2352 x 1568 pixels · 45° FOV — 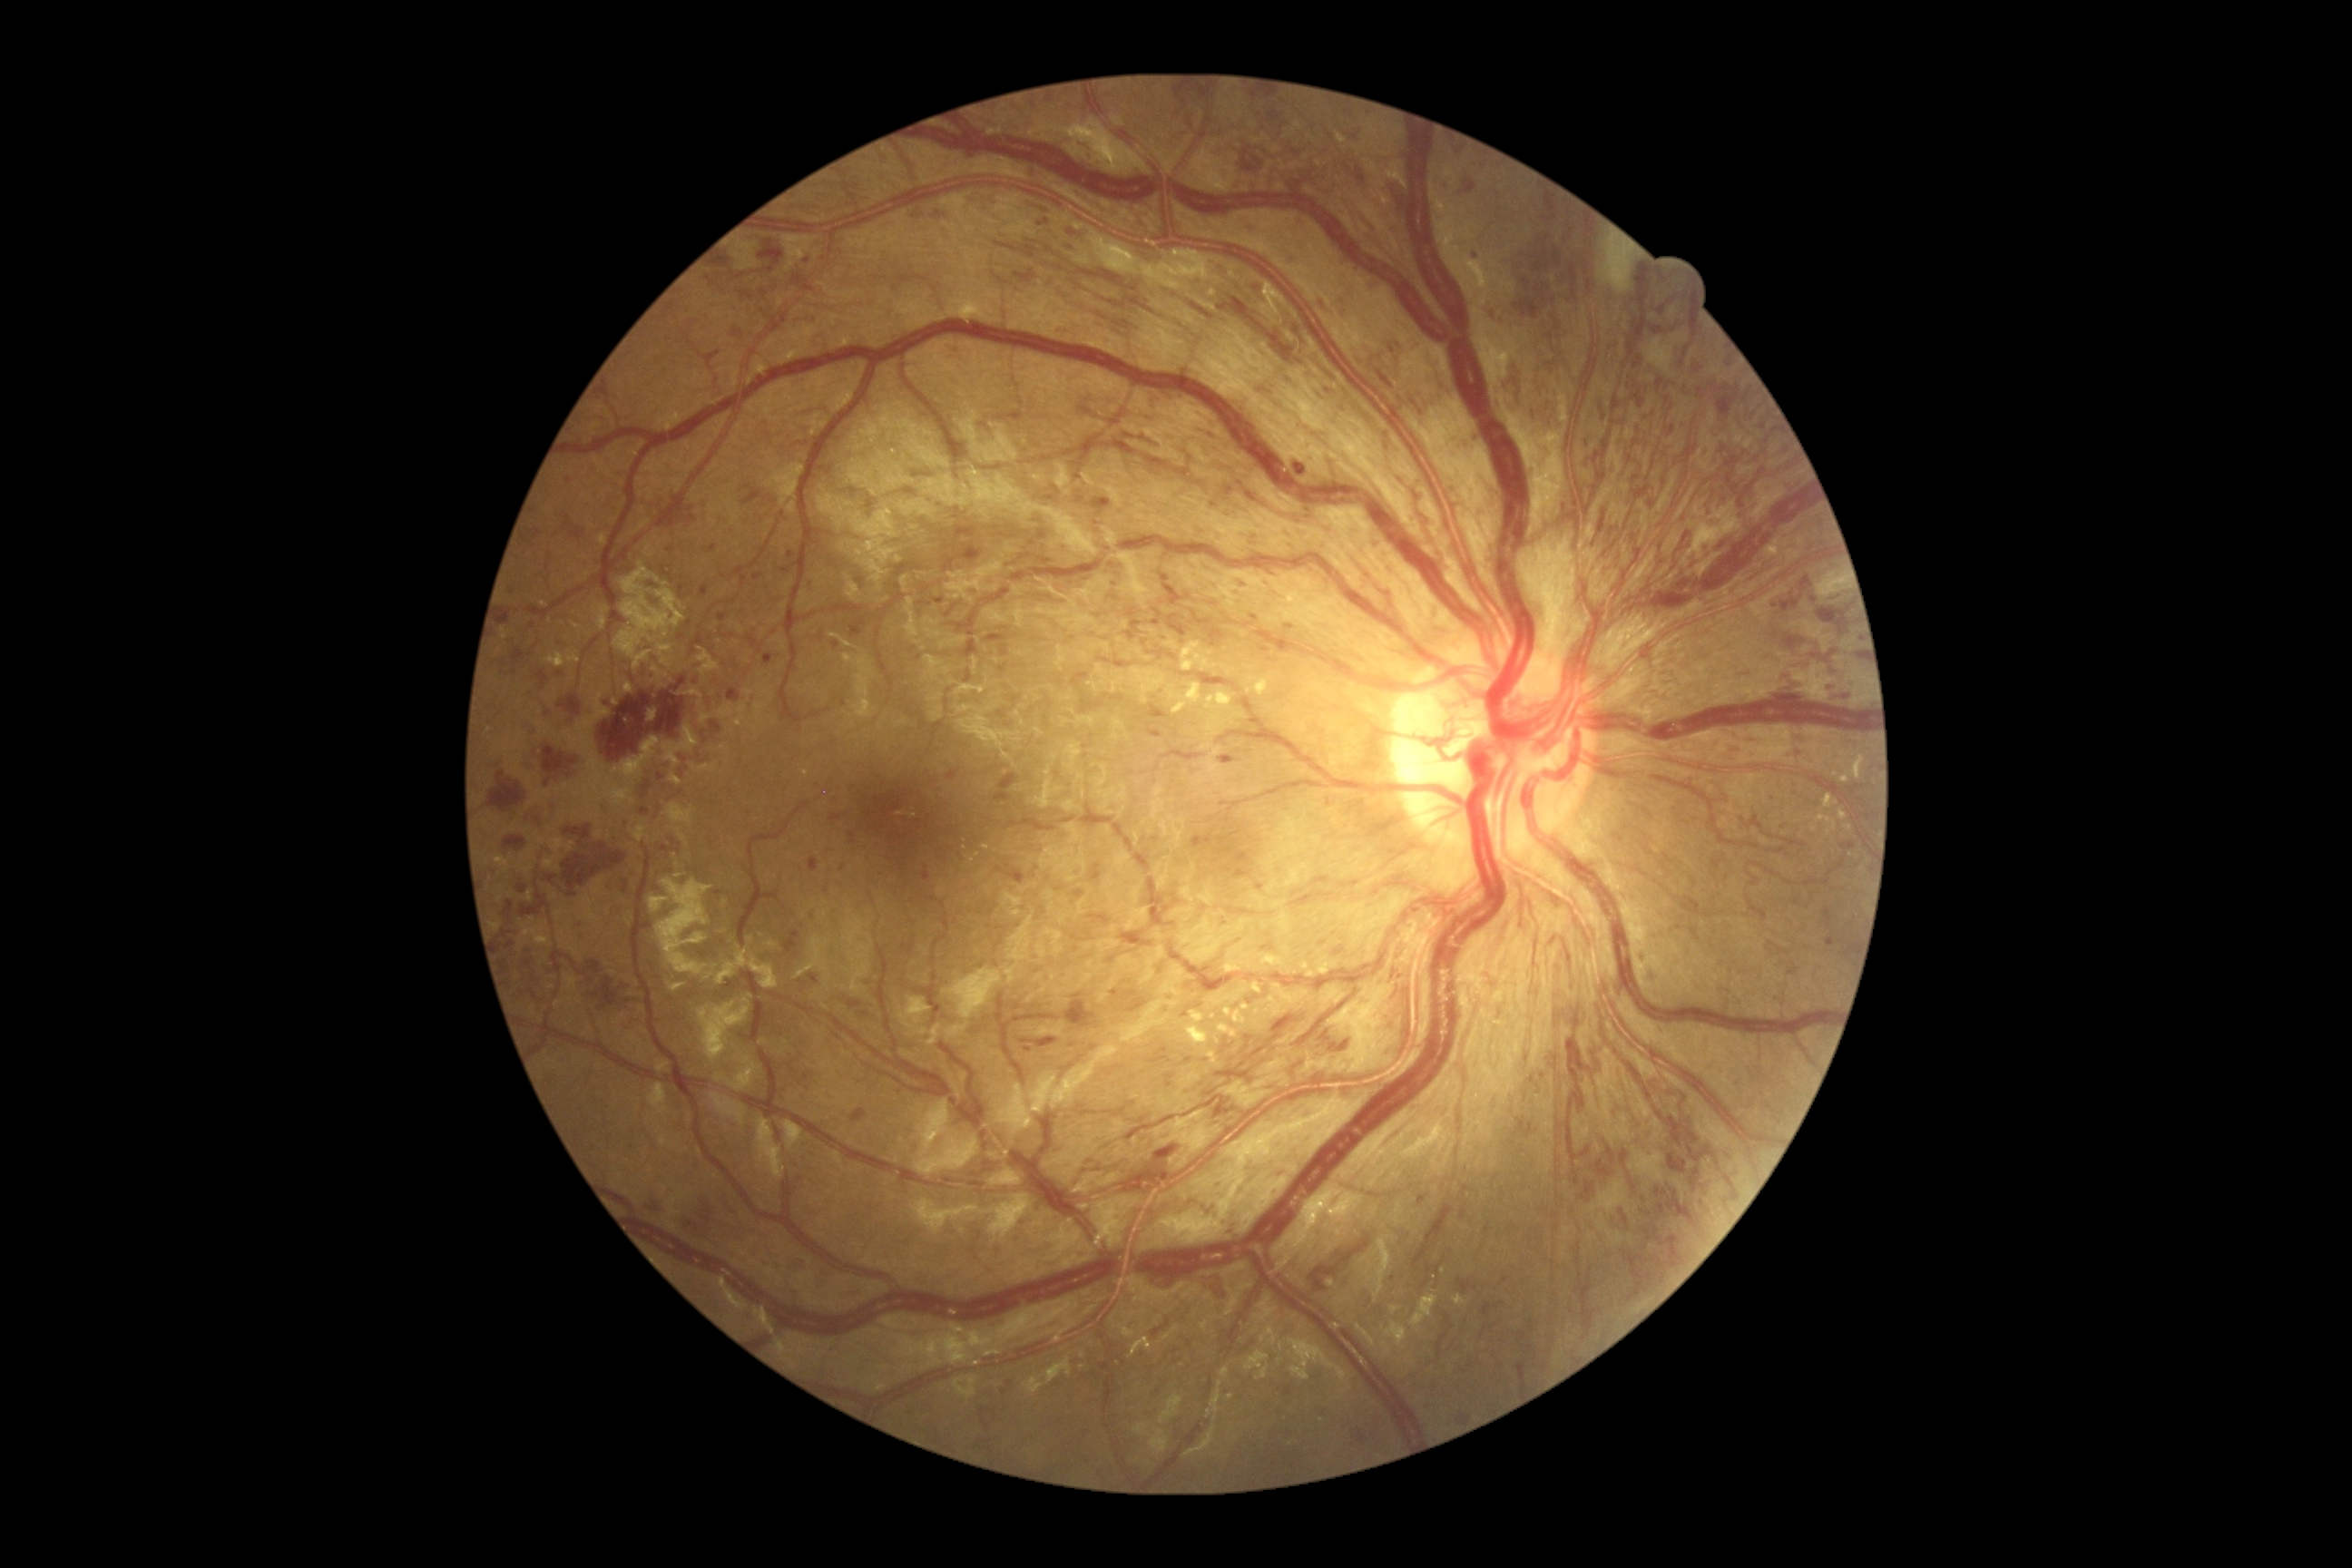 DR stage: grade 4 (PDR).